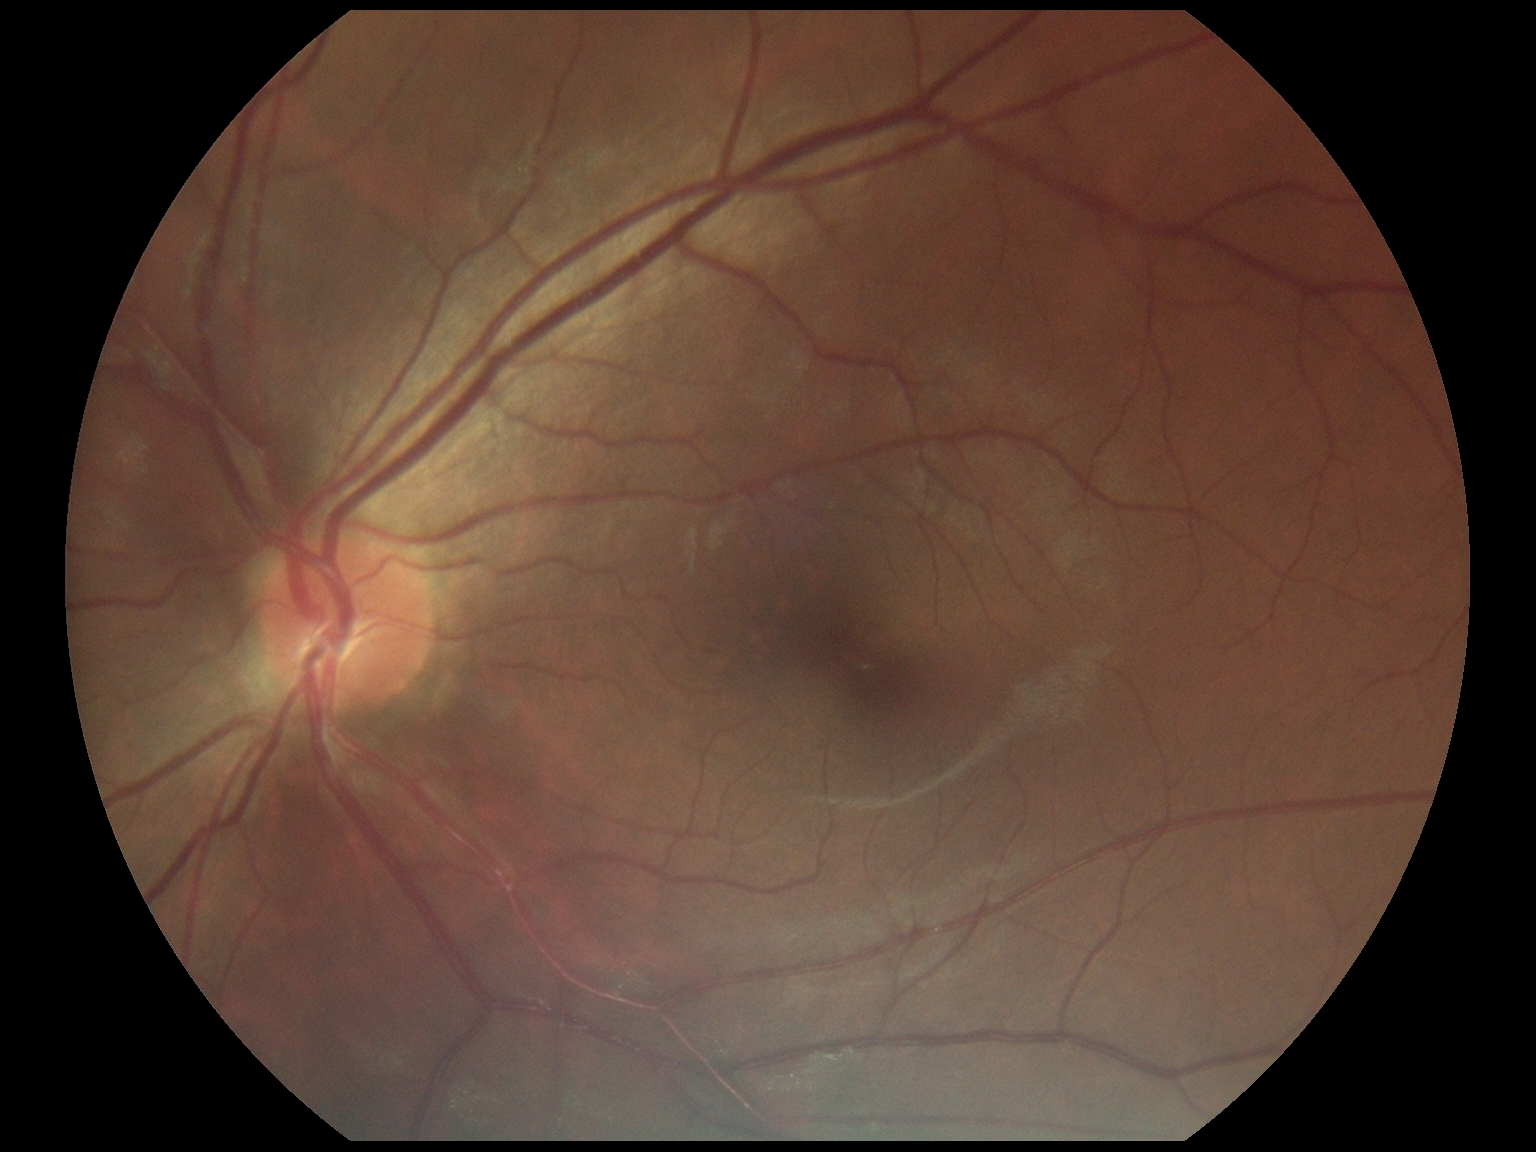 DR: 0/4.